Retinal fundus photograph
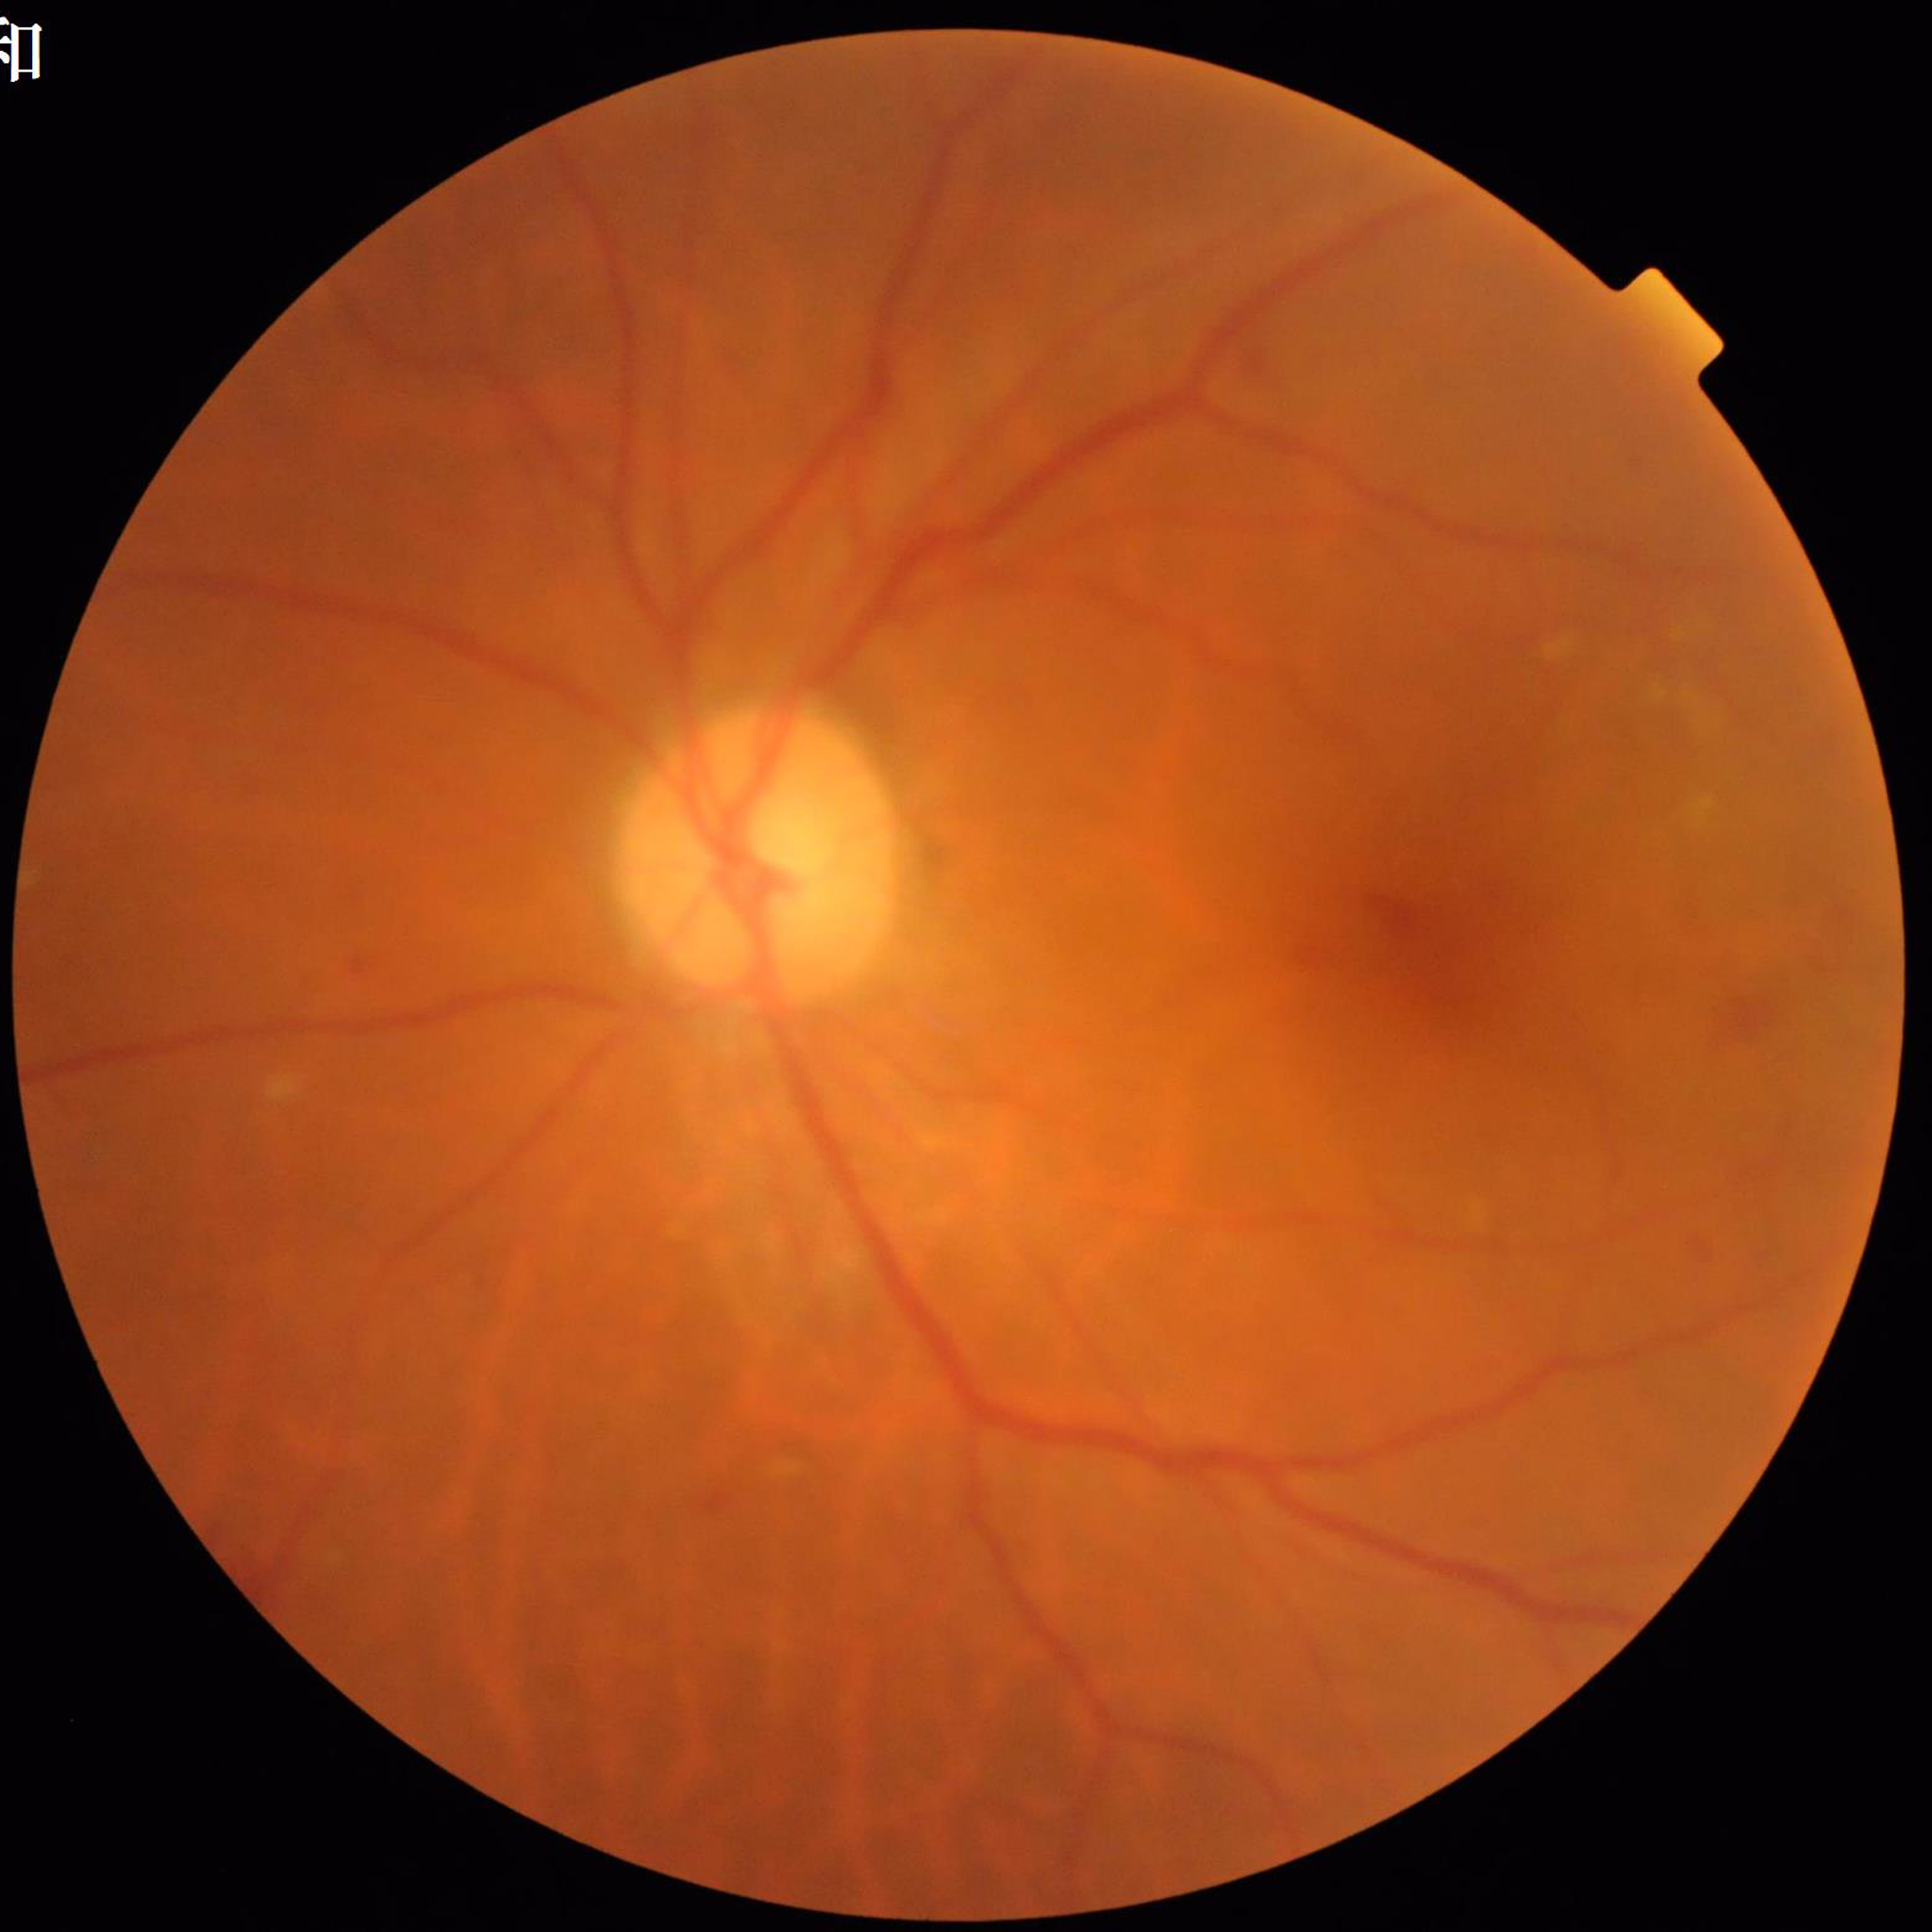
Diagnosis: diabetic retinopathy
Automated quality assessment: concerns include blur